Color fundus image — 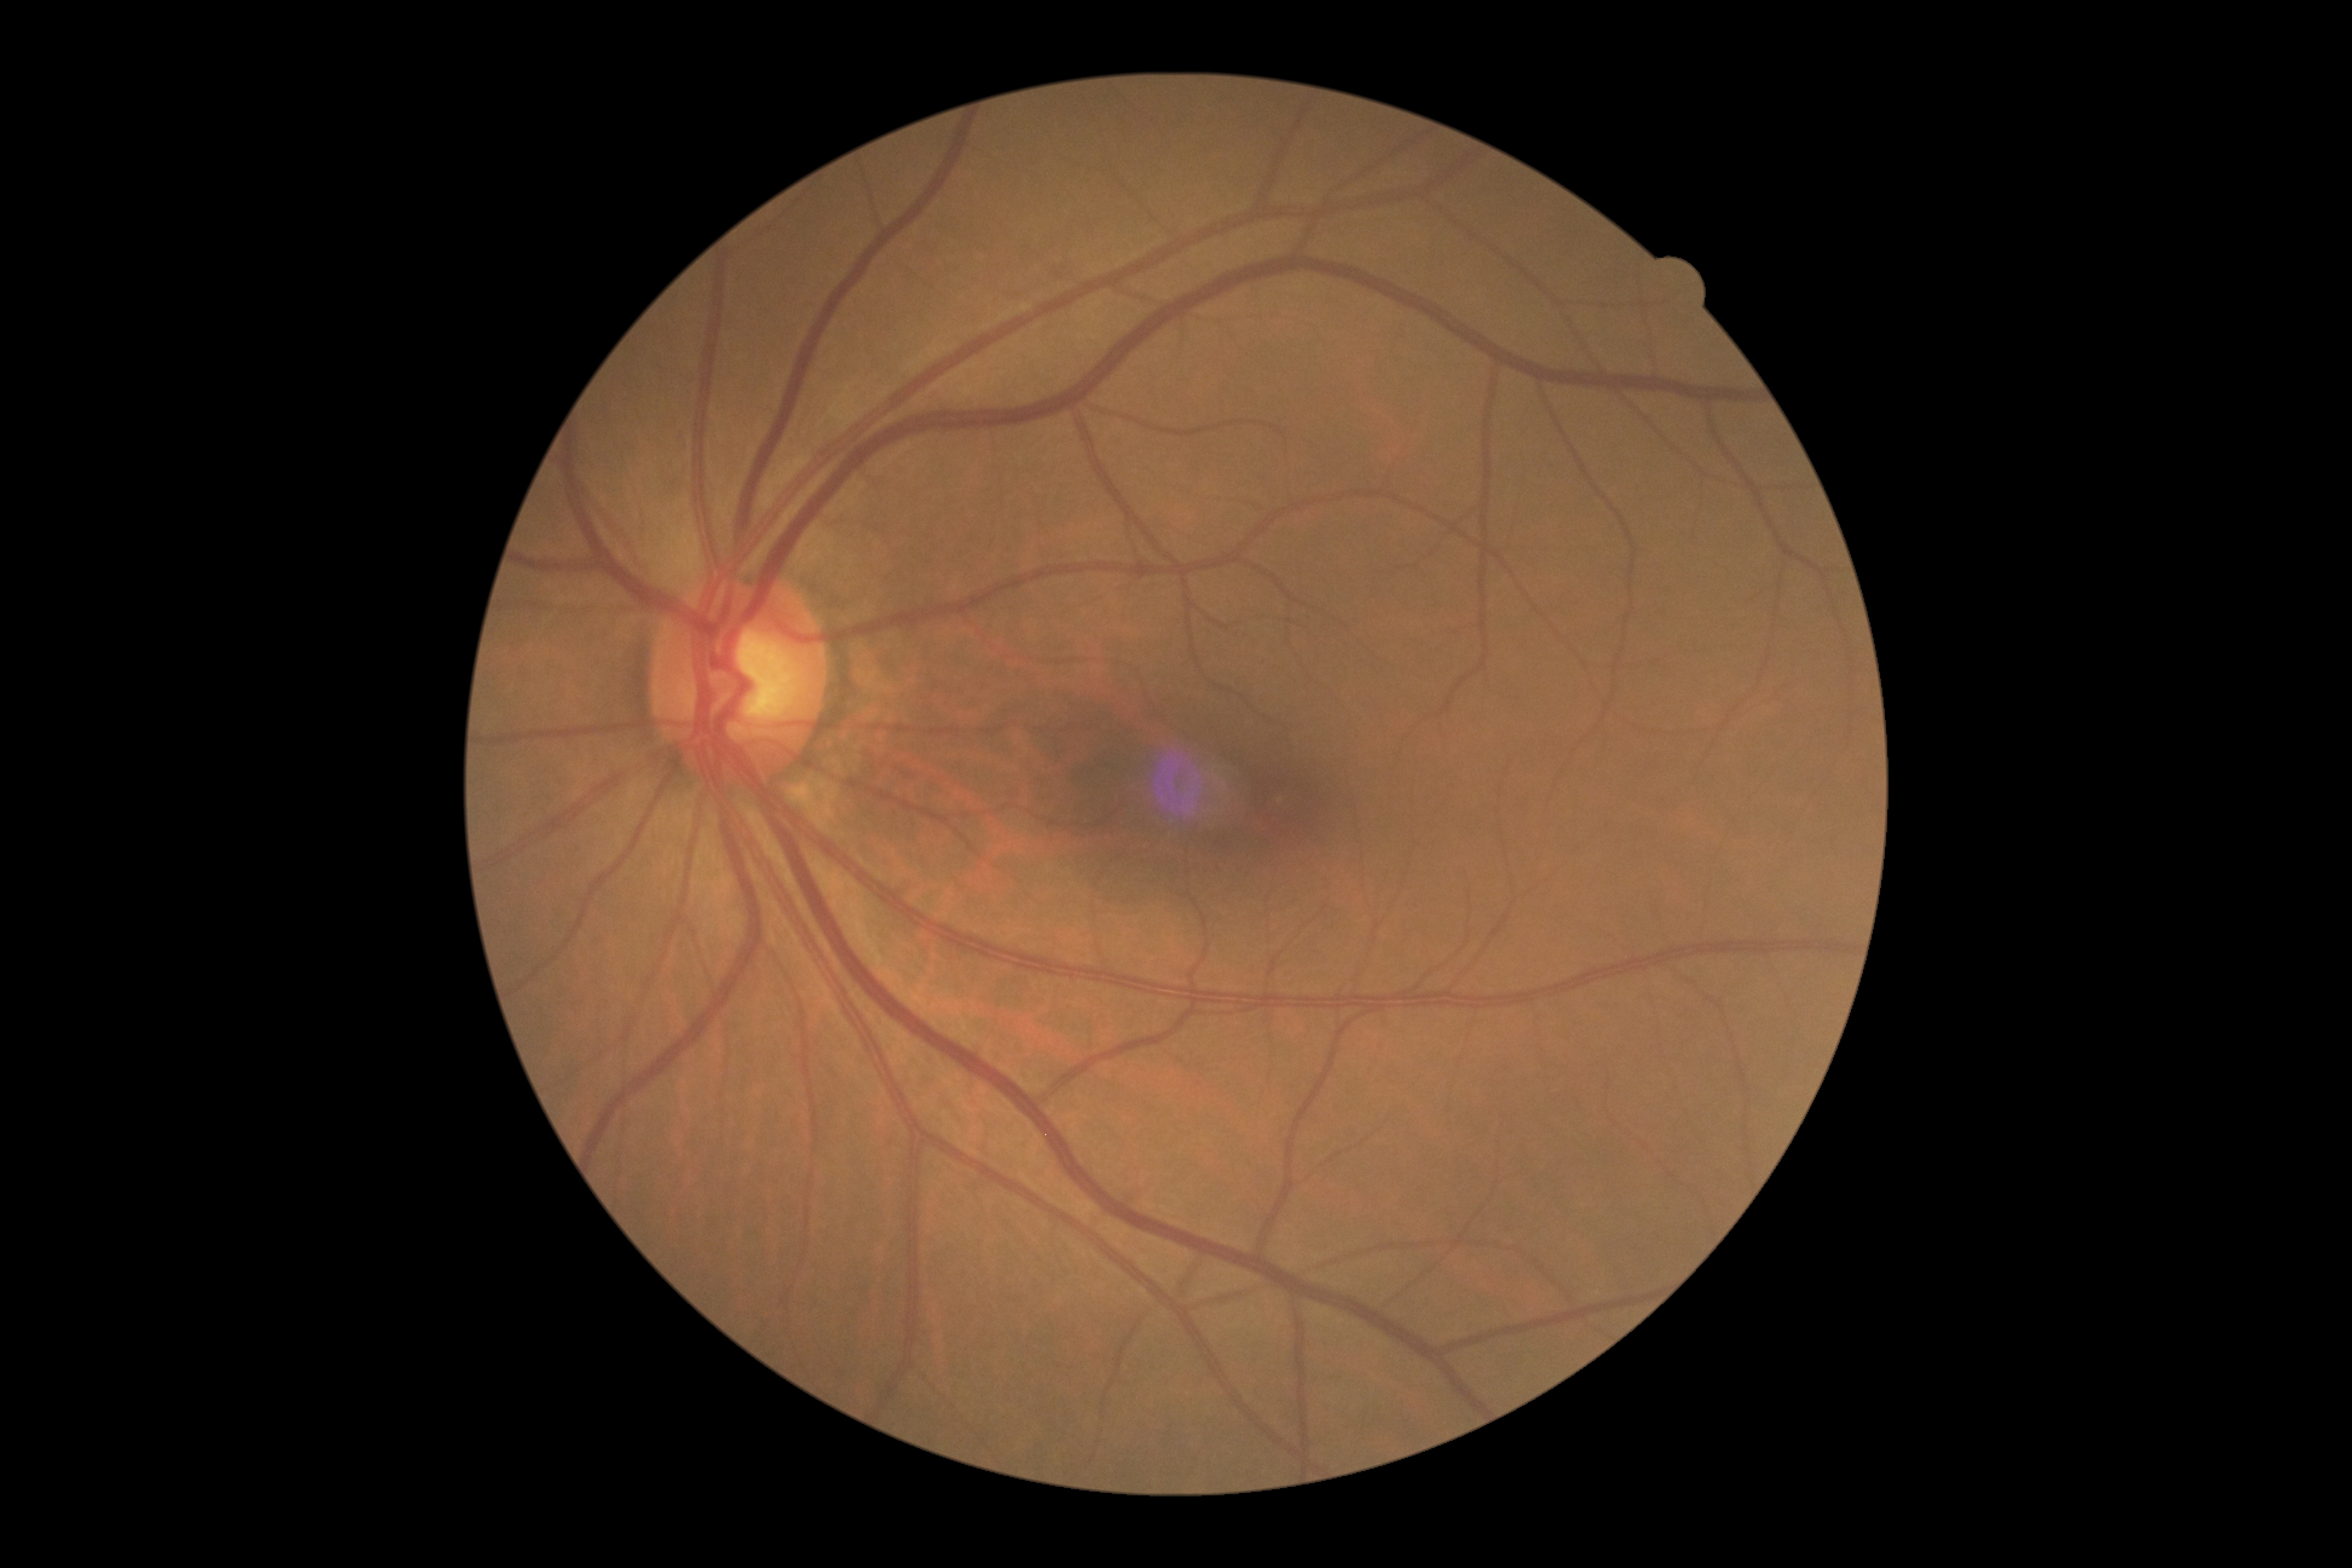 DR impression: no apparent DR, diabetic retinopathy: grade 0 (no apparent retinopathy).